2102x1736px. Fundus photo: 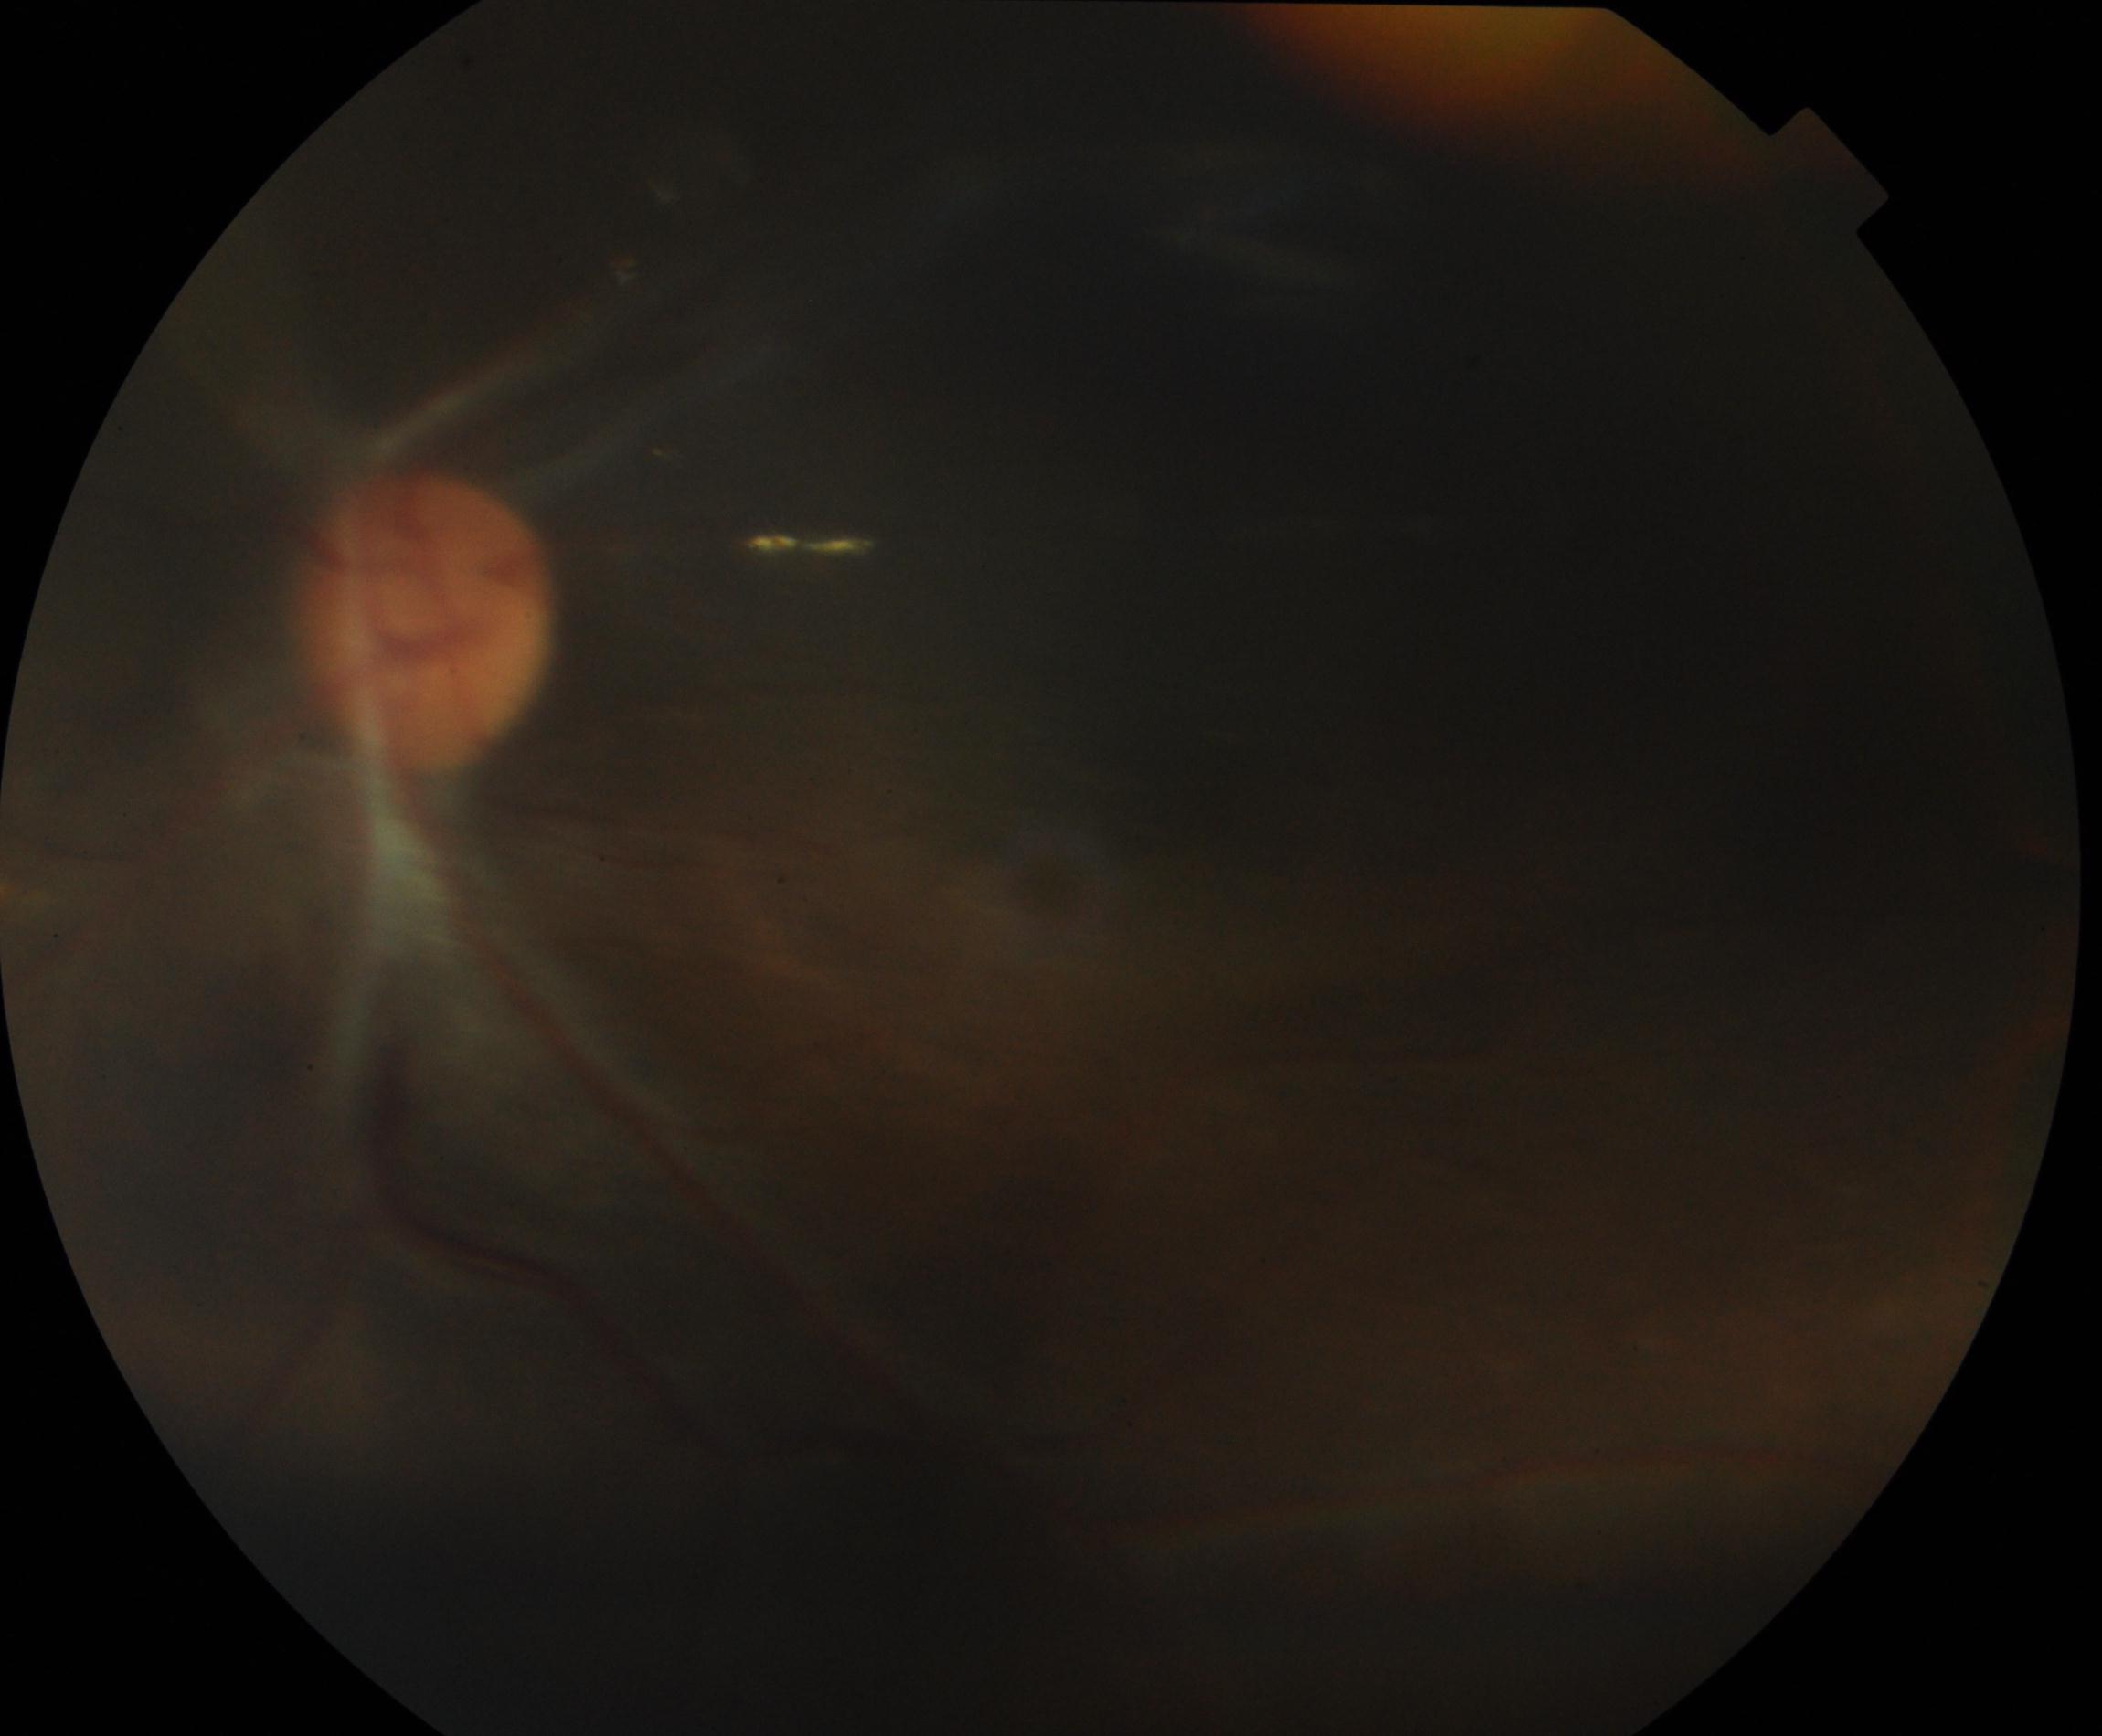 Image quality is poor; more than half the field is obscured. No proliferative diabetic retinopathy identified.